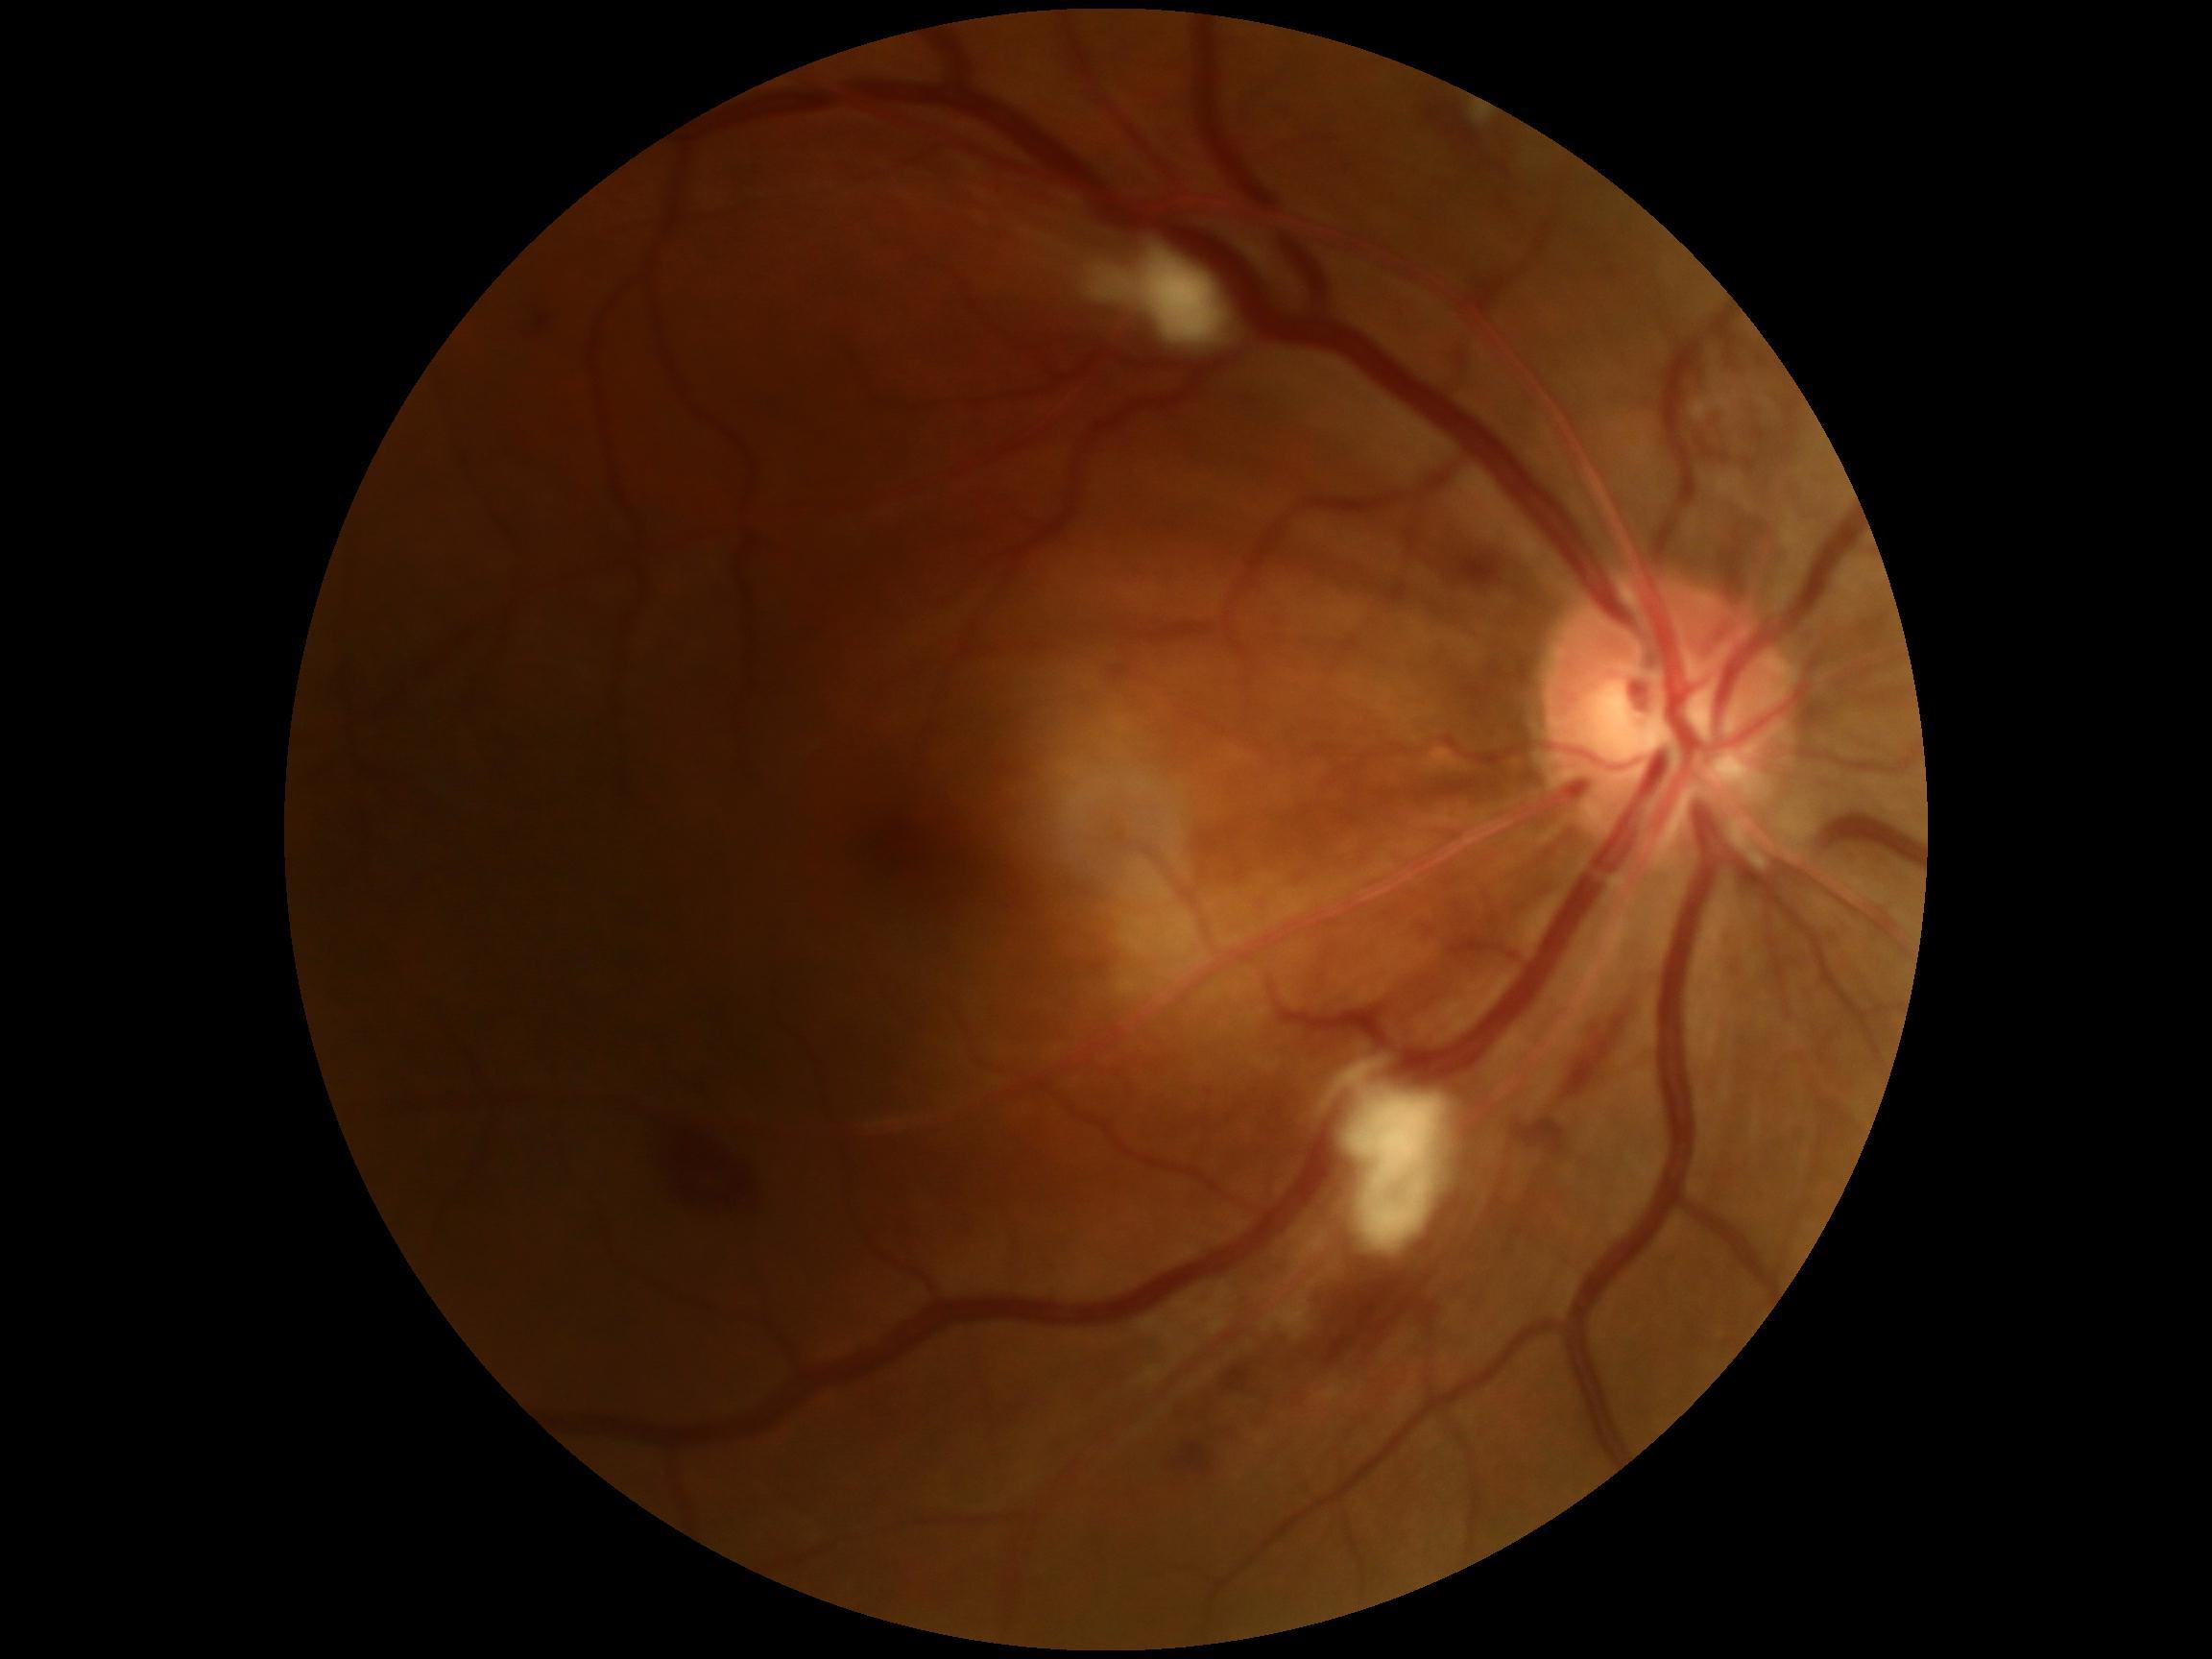 Diabetic retinopathy grade is 2/4.
Disease class: non-proliferative diabetic retinopathy.